1240 by 1240 pixels; infant wide-field fundus photograph — 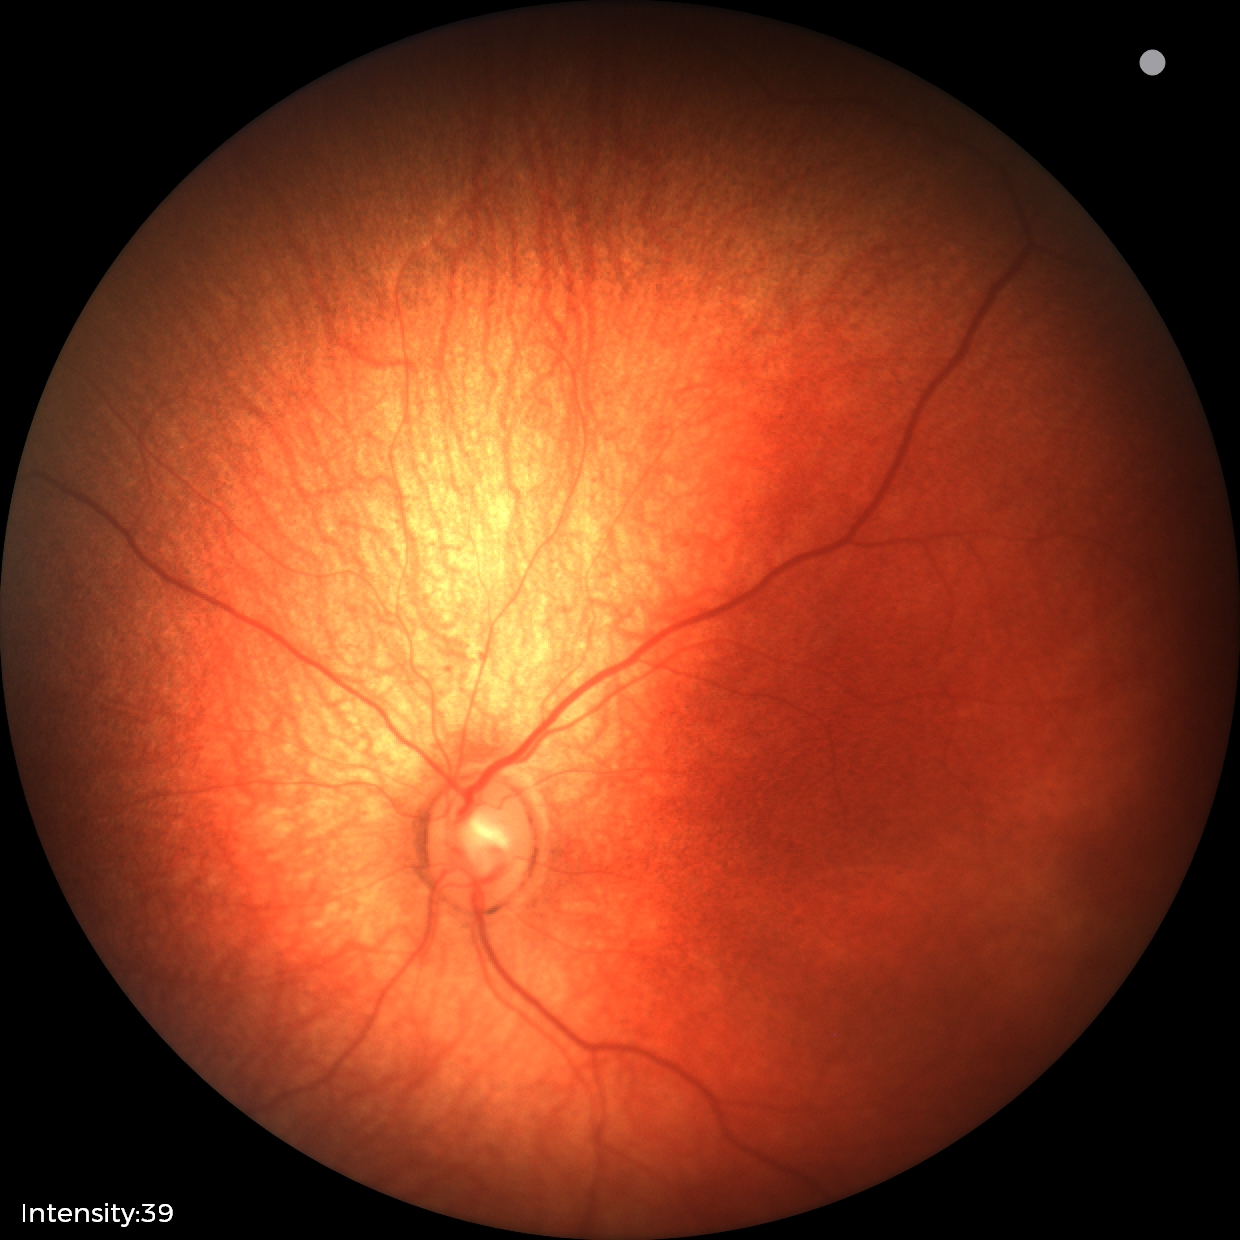

Screening diagnosis: physiological